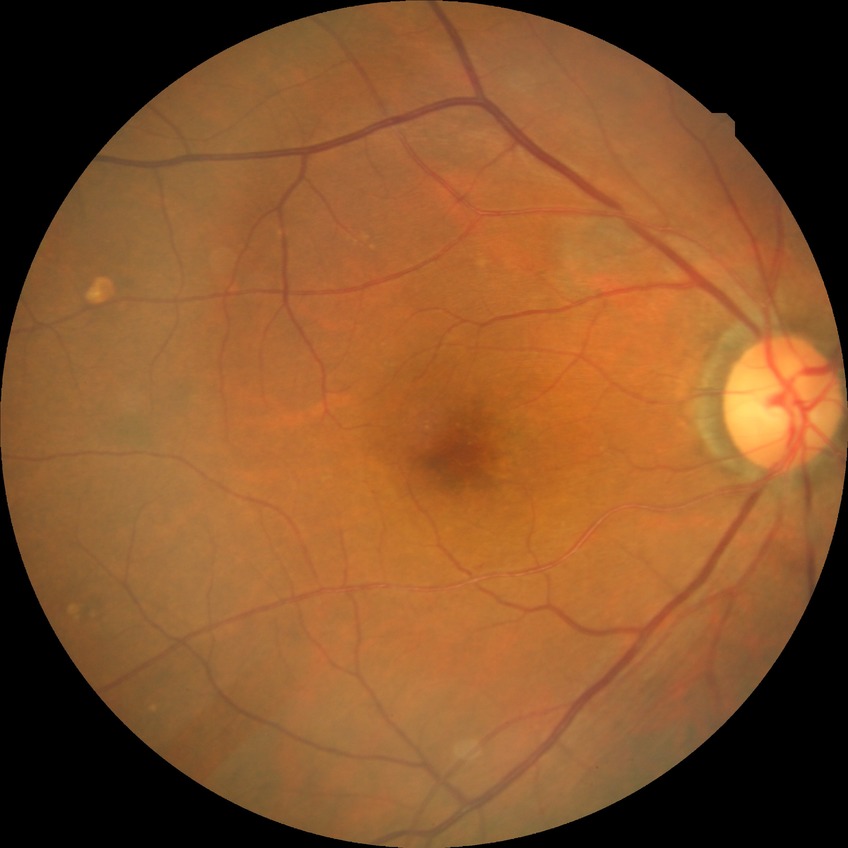
No signs of diabetic retinopathy. DR severity: NDR.